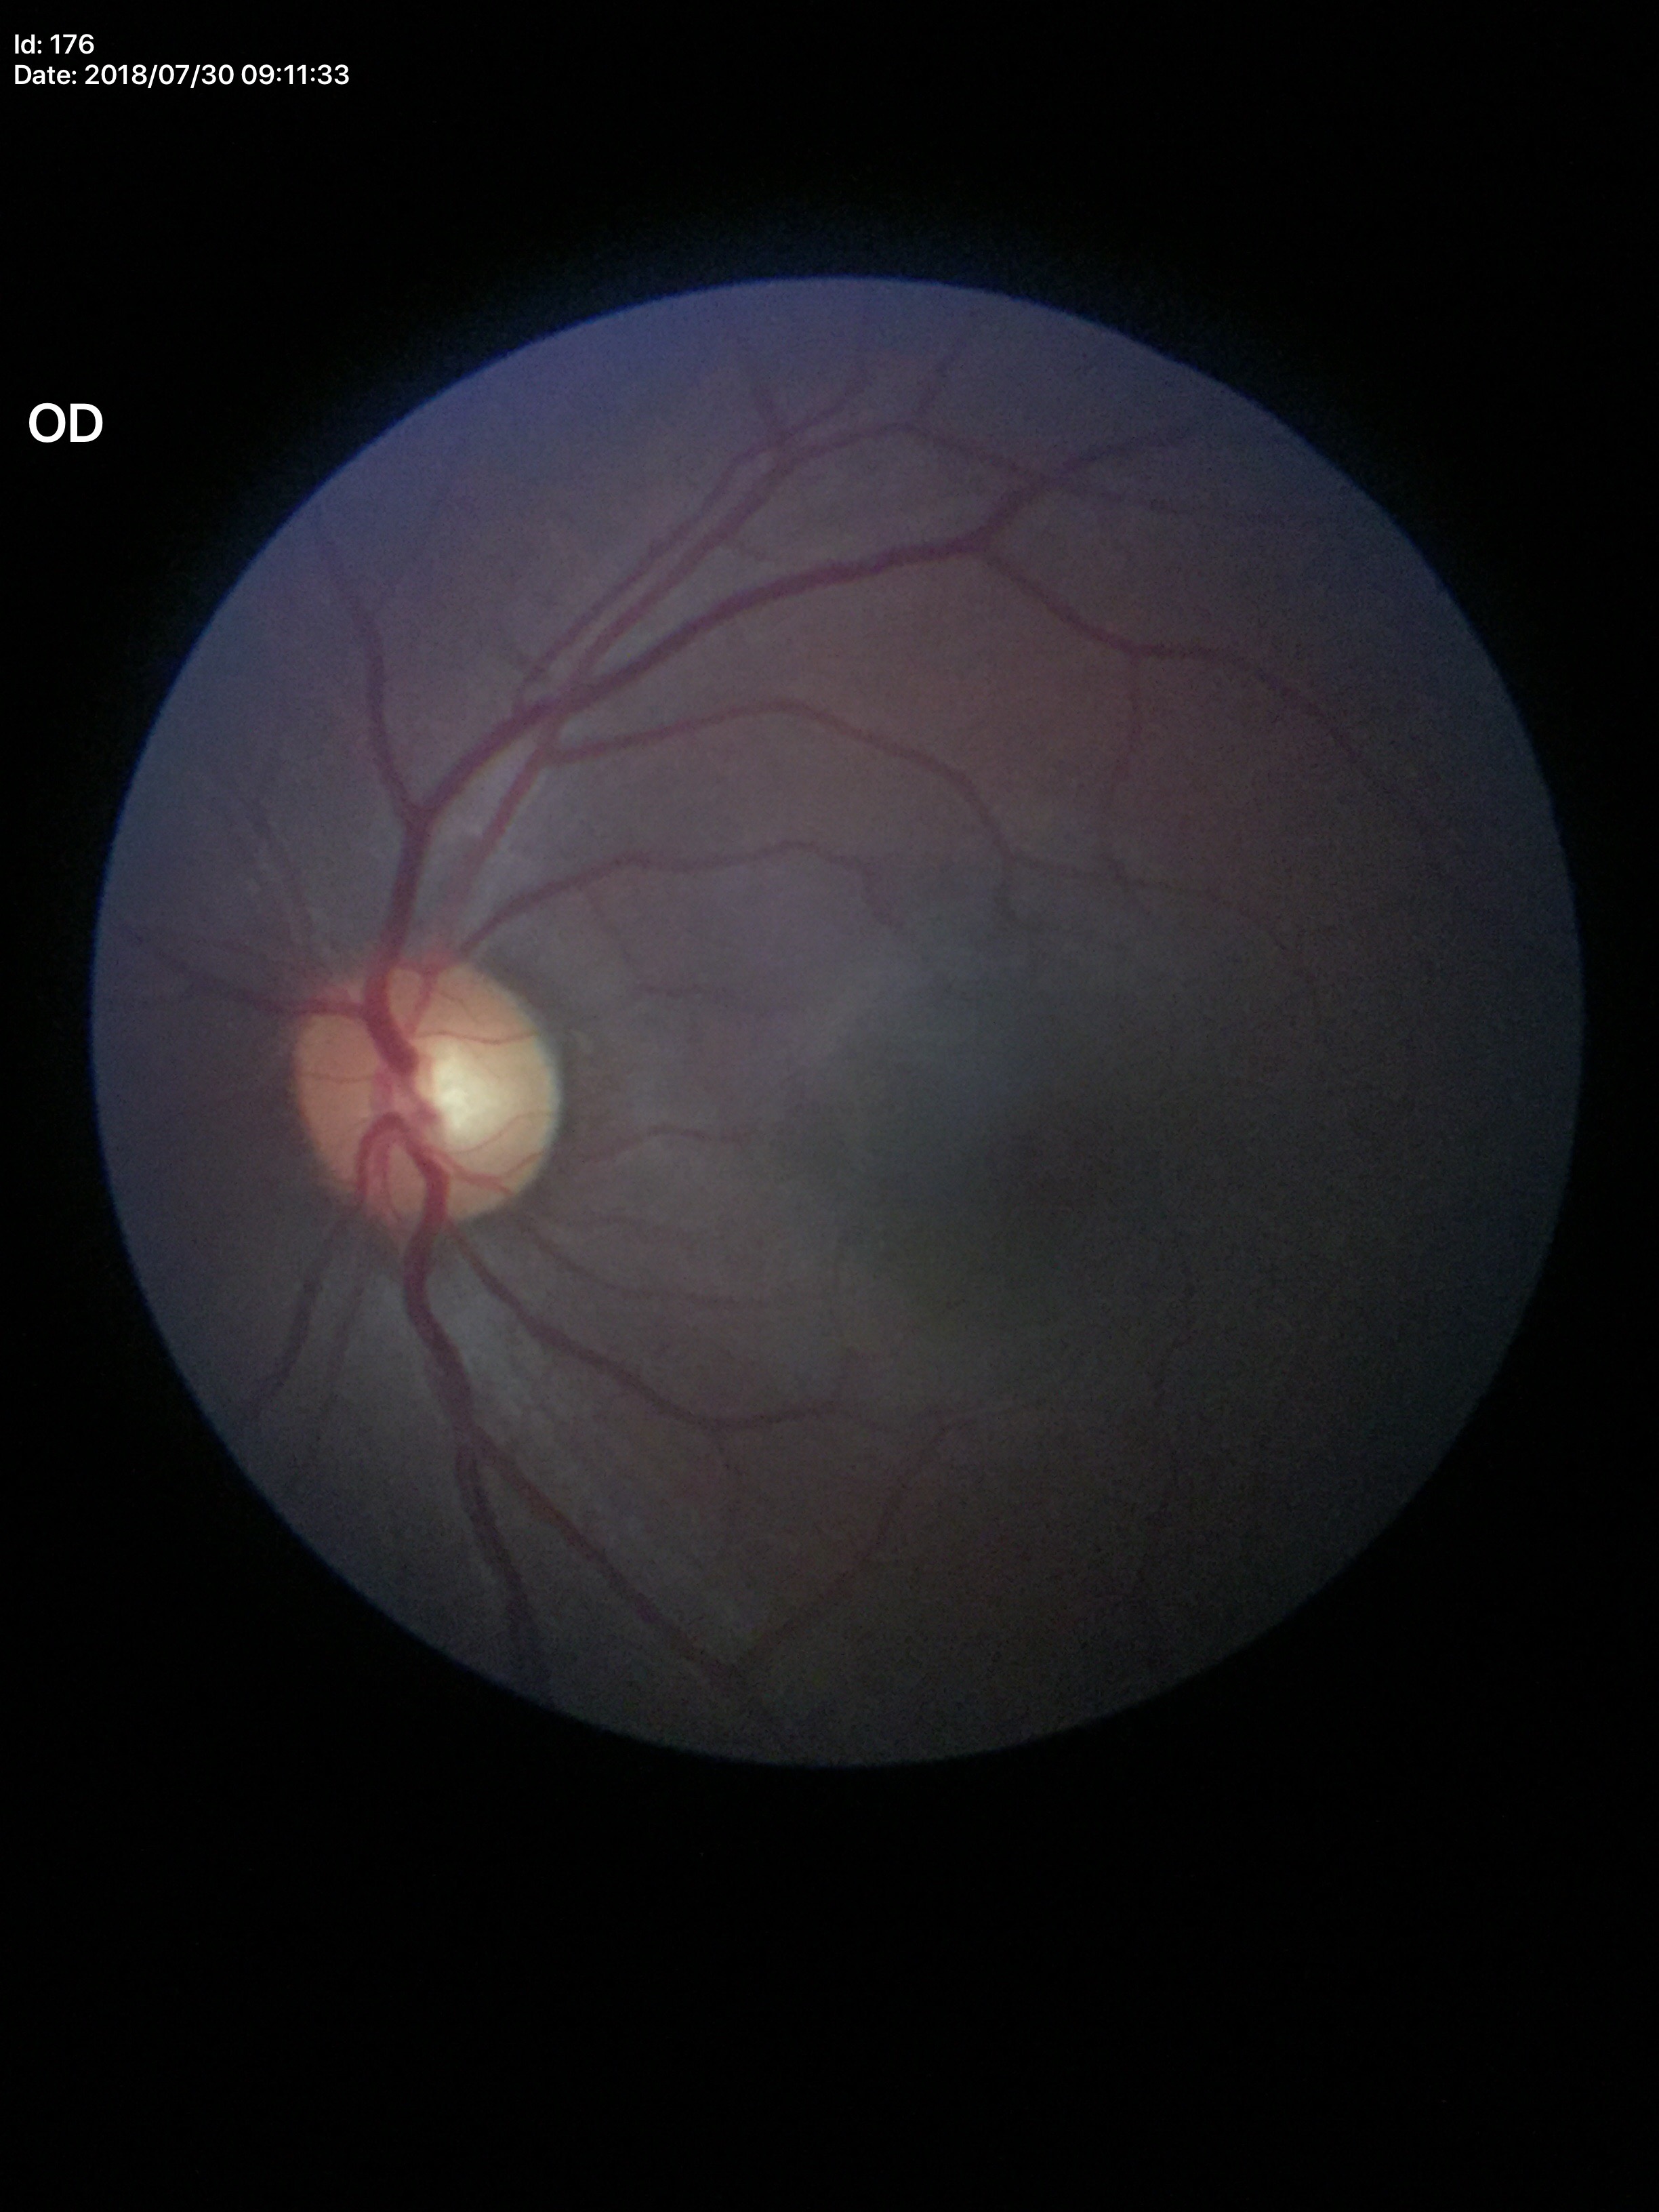

Findings:
- Glaucoma assessment · not suspect
- vertical cup-to-disc ratio · 0.52